Posterior pole photograph · 848 x 848 pixels · camera: NIDEK AFC-230: 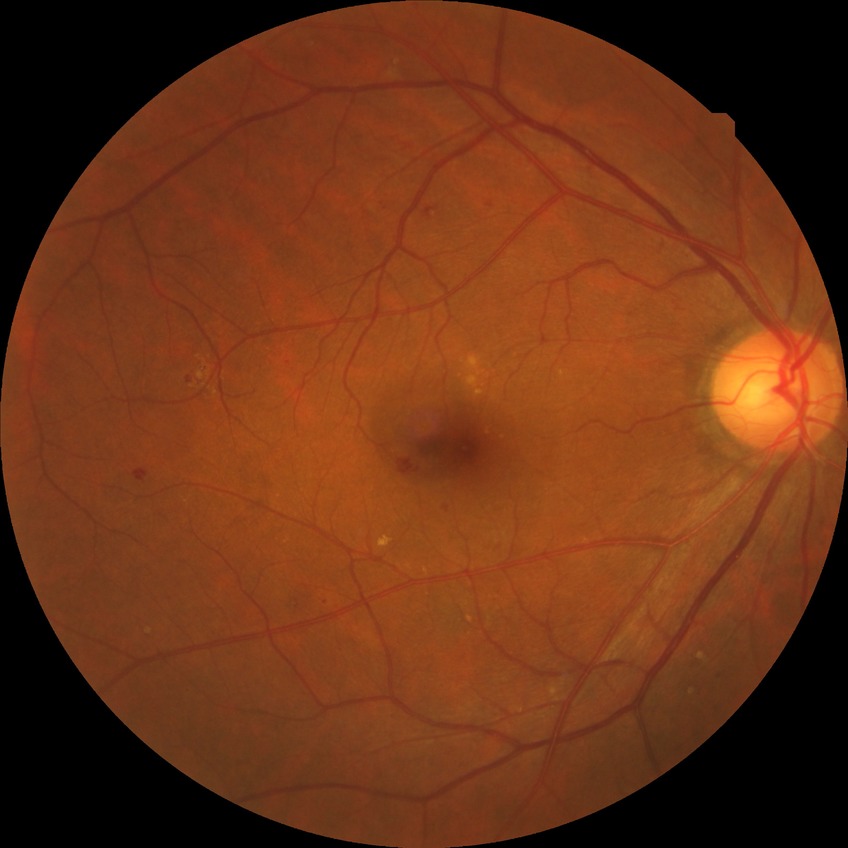

– diabetic retinopathy (DR): simple diabetic retinopathy (SDR)
– DR class: non-proliferative diabetic retinopathy